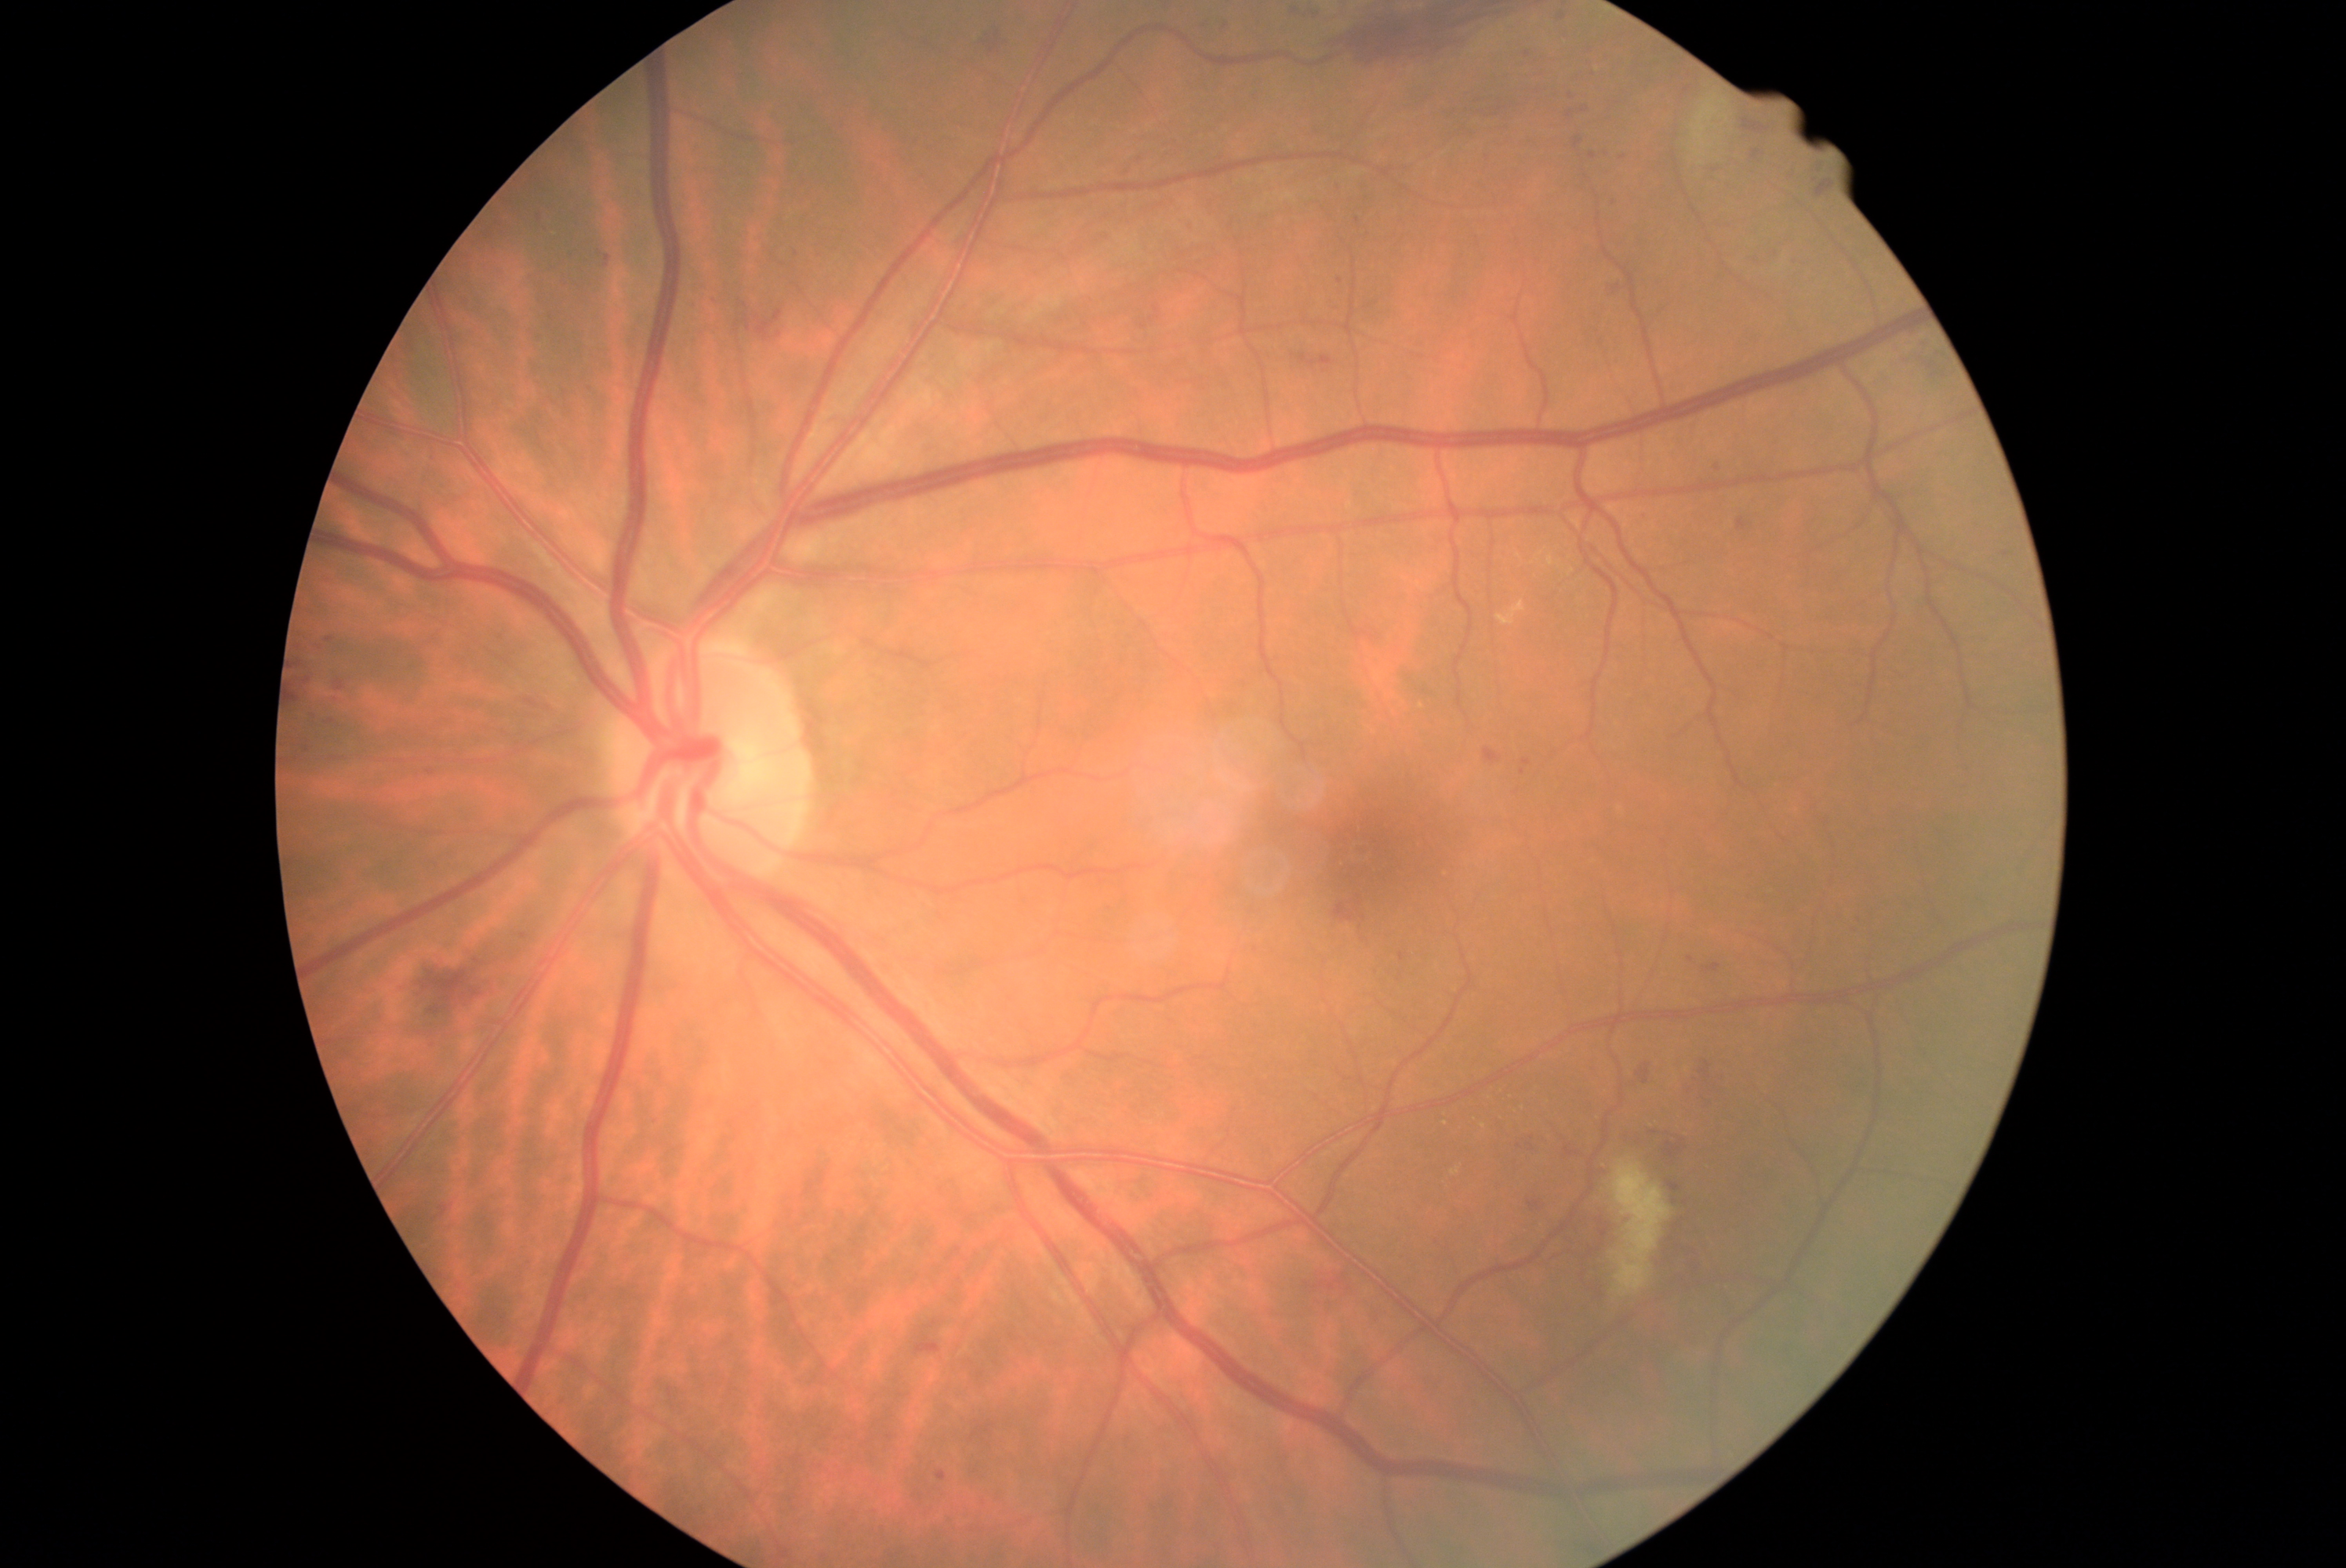
Diabetic retinopathy grade is 2/4; non-proliferative diabetic retinopathy.
Microaneurysms include [x1=606, y1=256, x2=611, y2=267]; [x1=1574, y1=139, x2=1585, y2=148]; [x1=427, y1=771, x2=435, y2=775]; [x1=1589, y1=153, x2=1597, y2=159]; [x1=1738, y1=520, x2=1746, y2=531]; [x1=1752, y1=151, x2=1760, y2=159]; [x1=327, y1=637, x2=335, y2=644]; [x1=937, y1=1472, x2=946, y2=1483]; [x1=1771, y1=252, x2=1779, y2=261]; [x1=1199, y1=24, x2=1211, y2=35].
Microaneurysms (small, approximate centers) near (1563,18); (1692,961); (1523,772); (333,722); (1617,206).